Retinal fundus photograph:
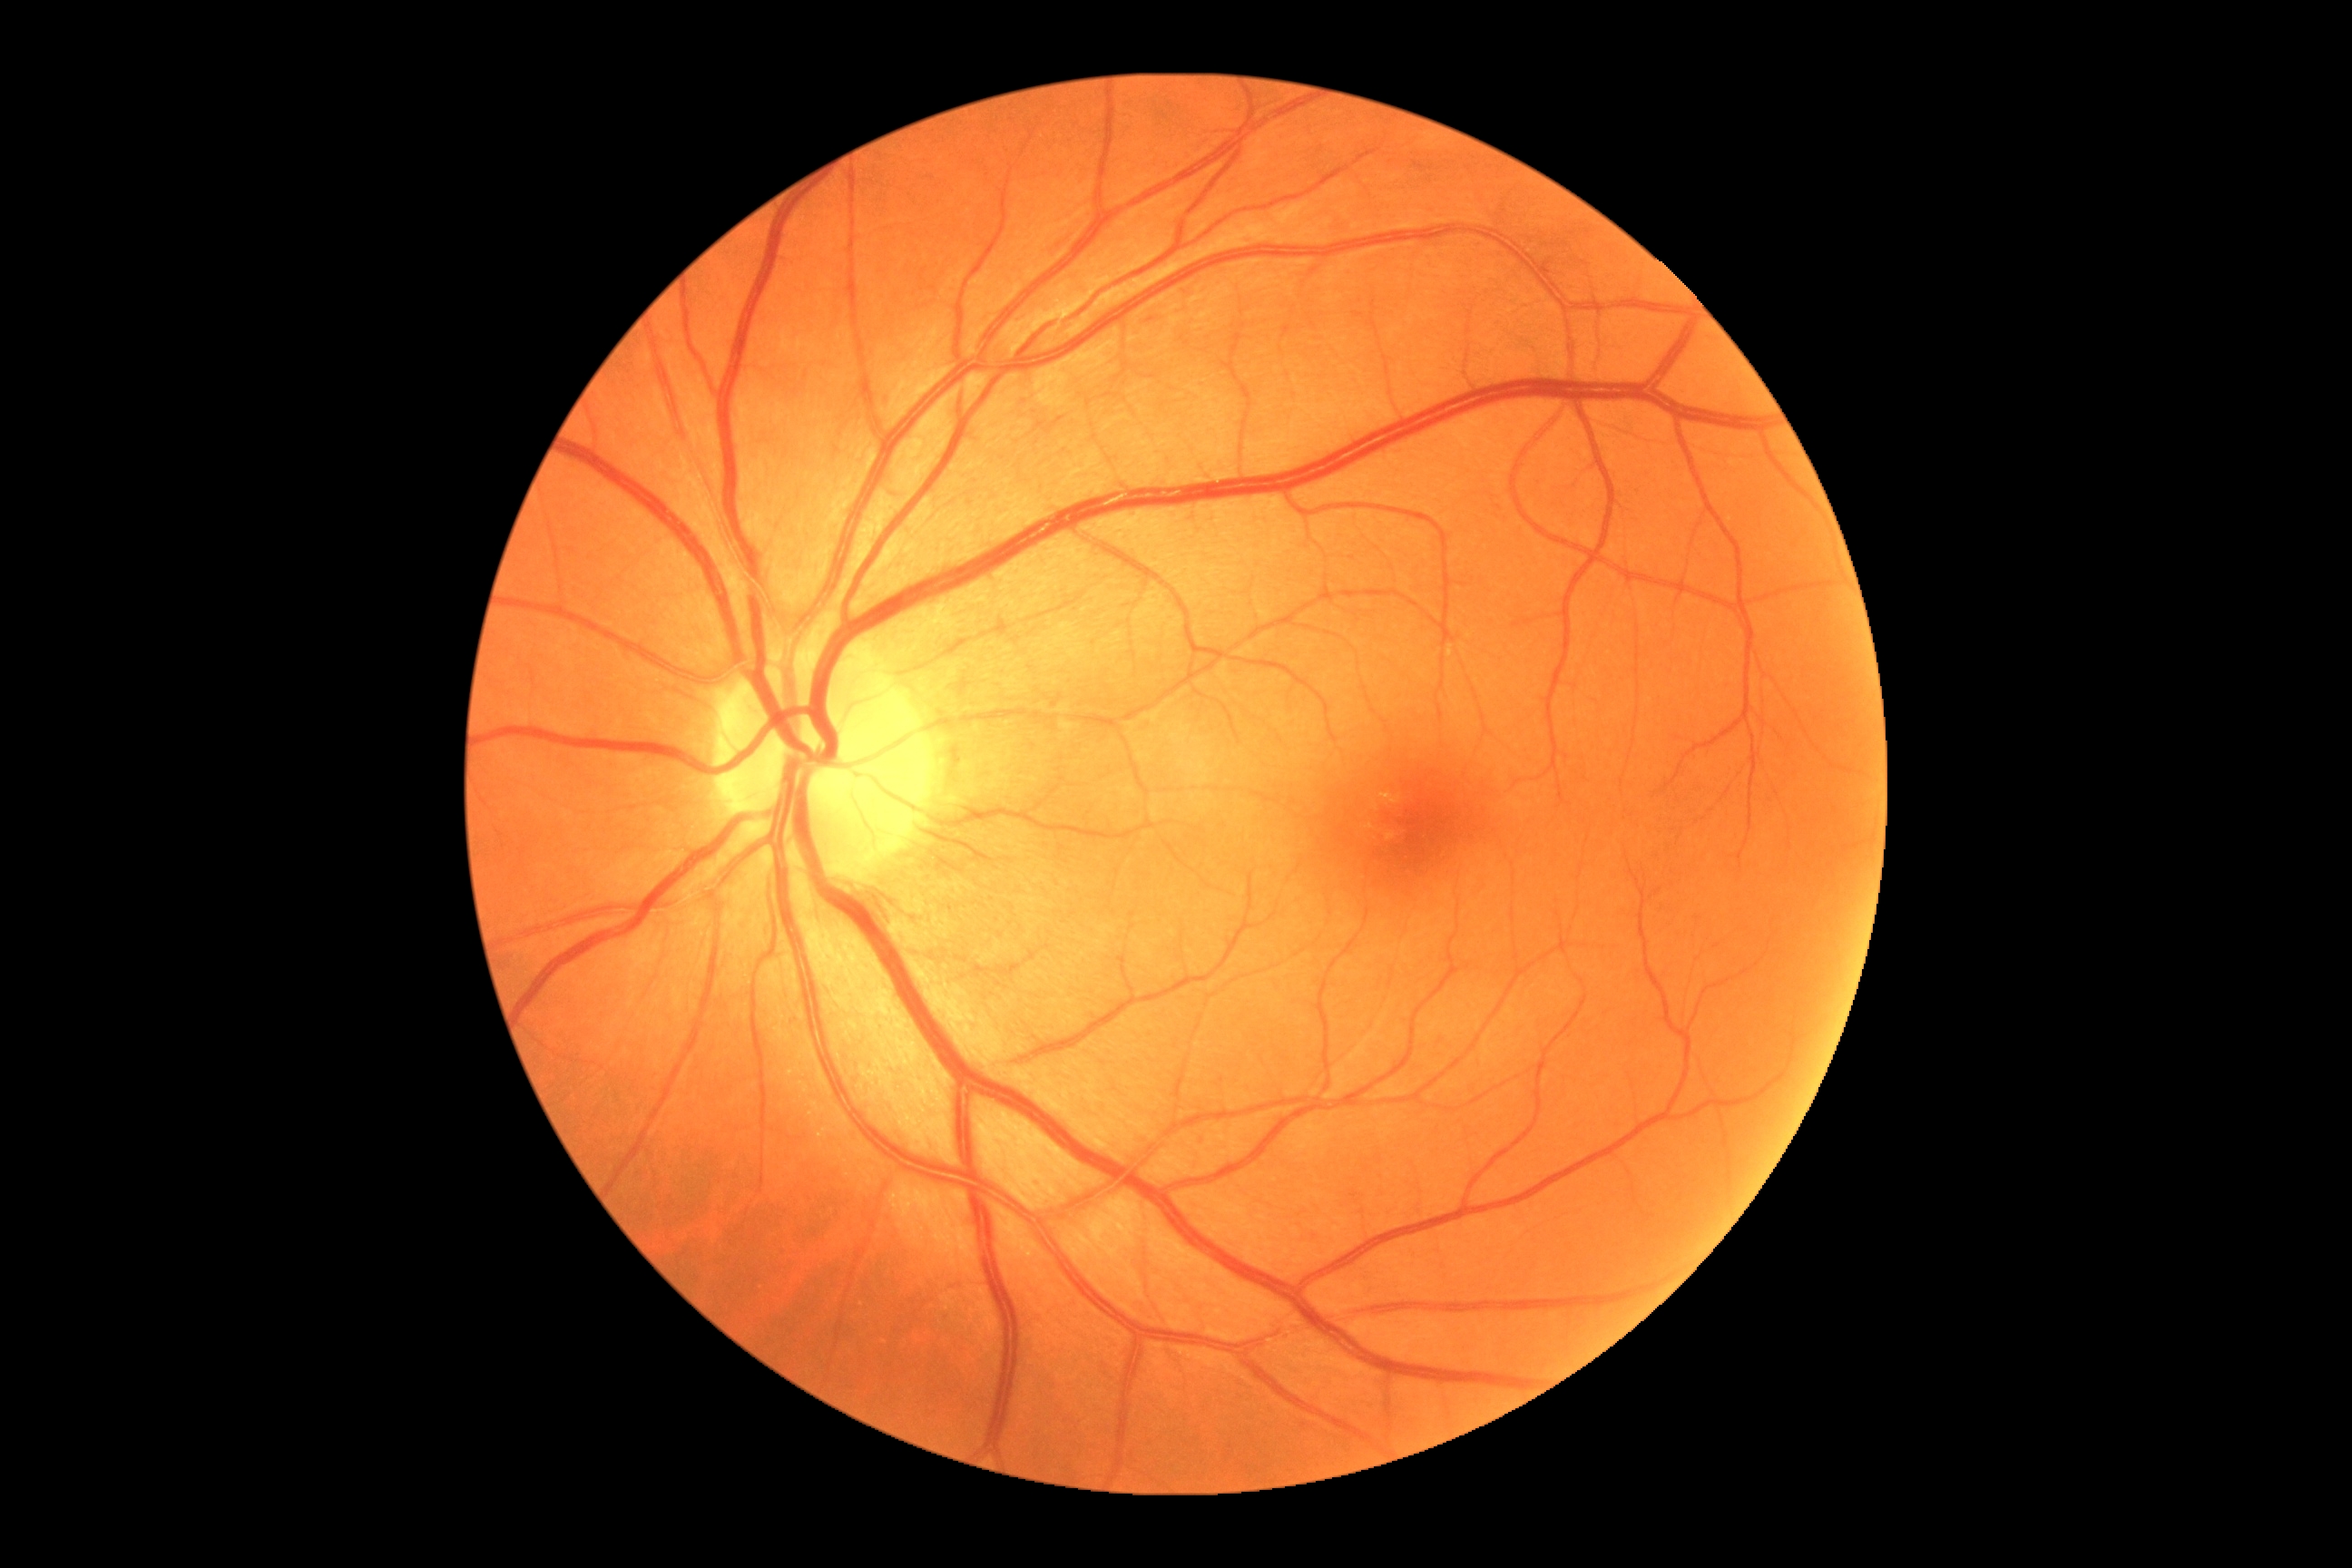
No DR findings.
Diabetic retinopathy (DR): no apparent diabetic retinopathy (grade 0).